Infant wide-field retinal image
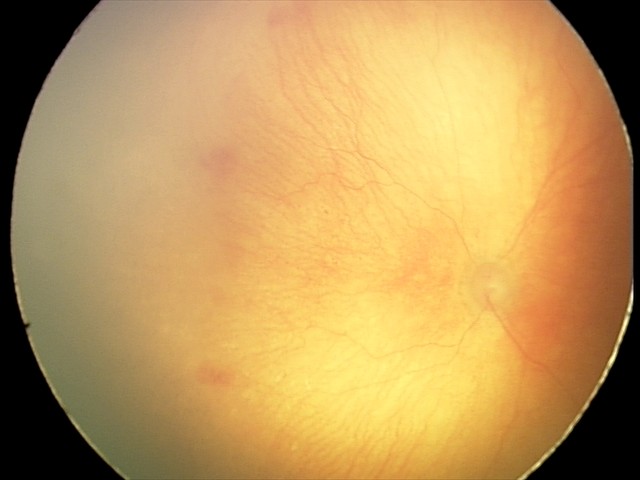

Diagnosis from this screening exam: aggressive ROP (A-ROP). Plus disease was diagnosed.